CFP:
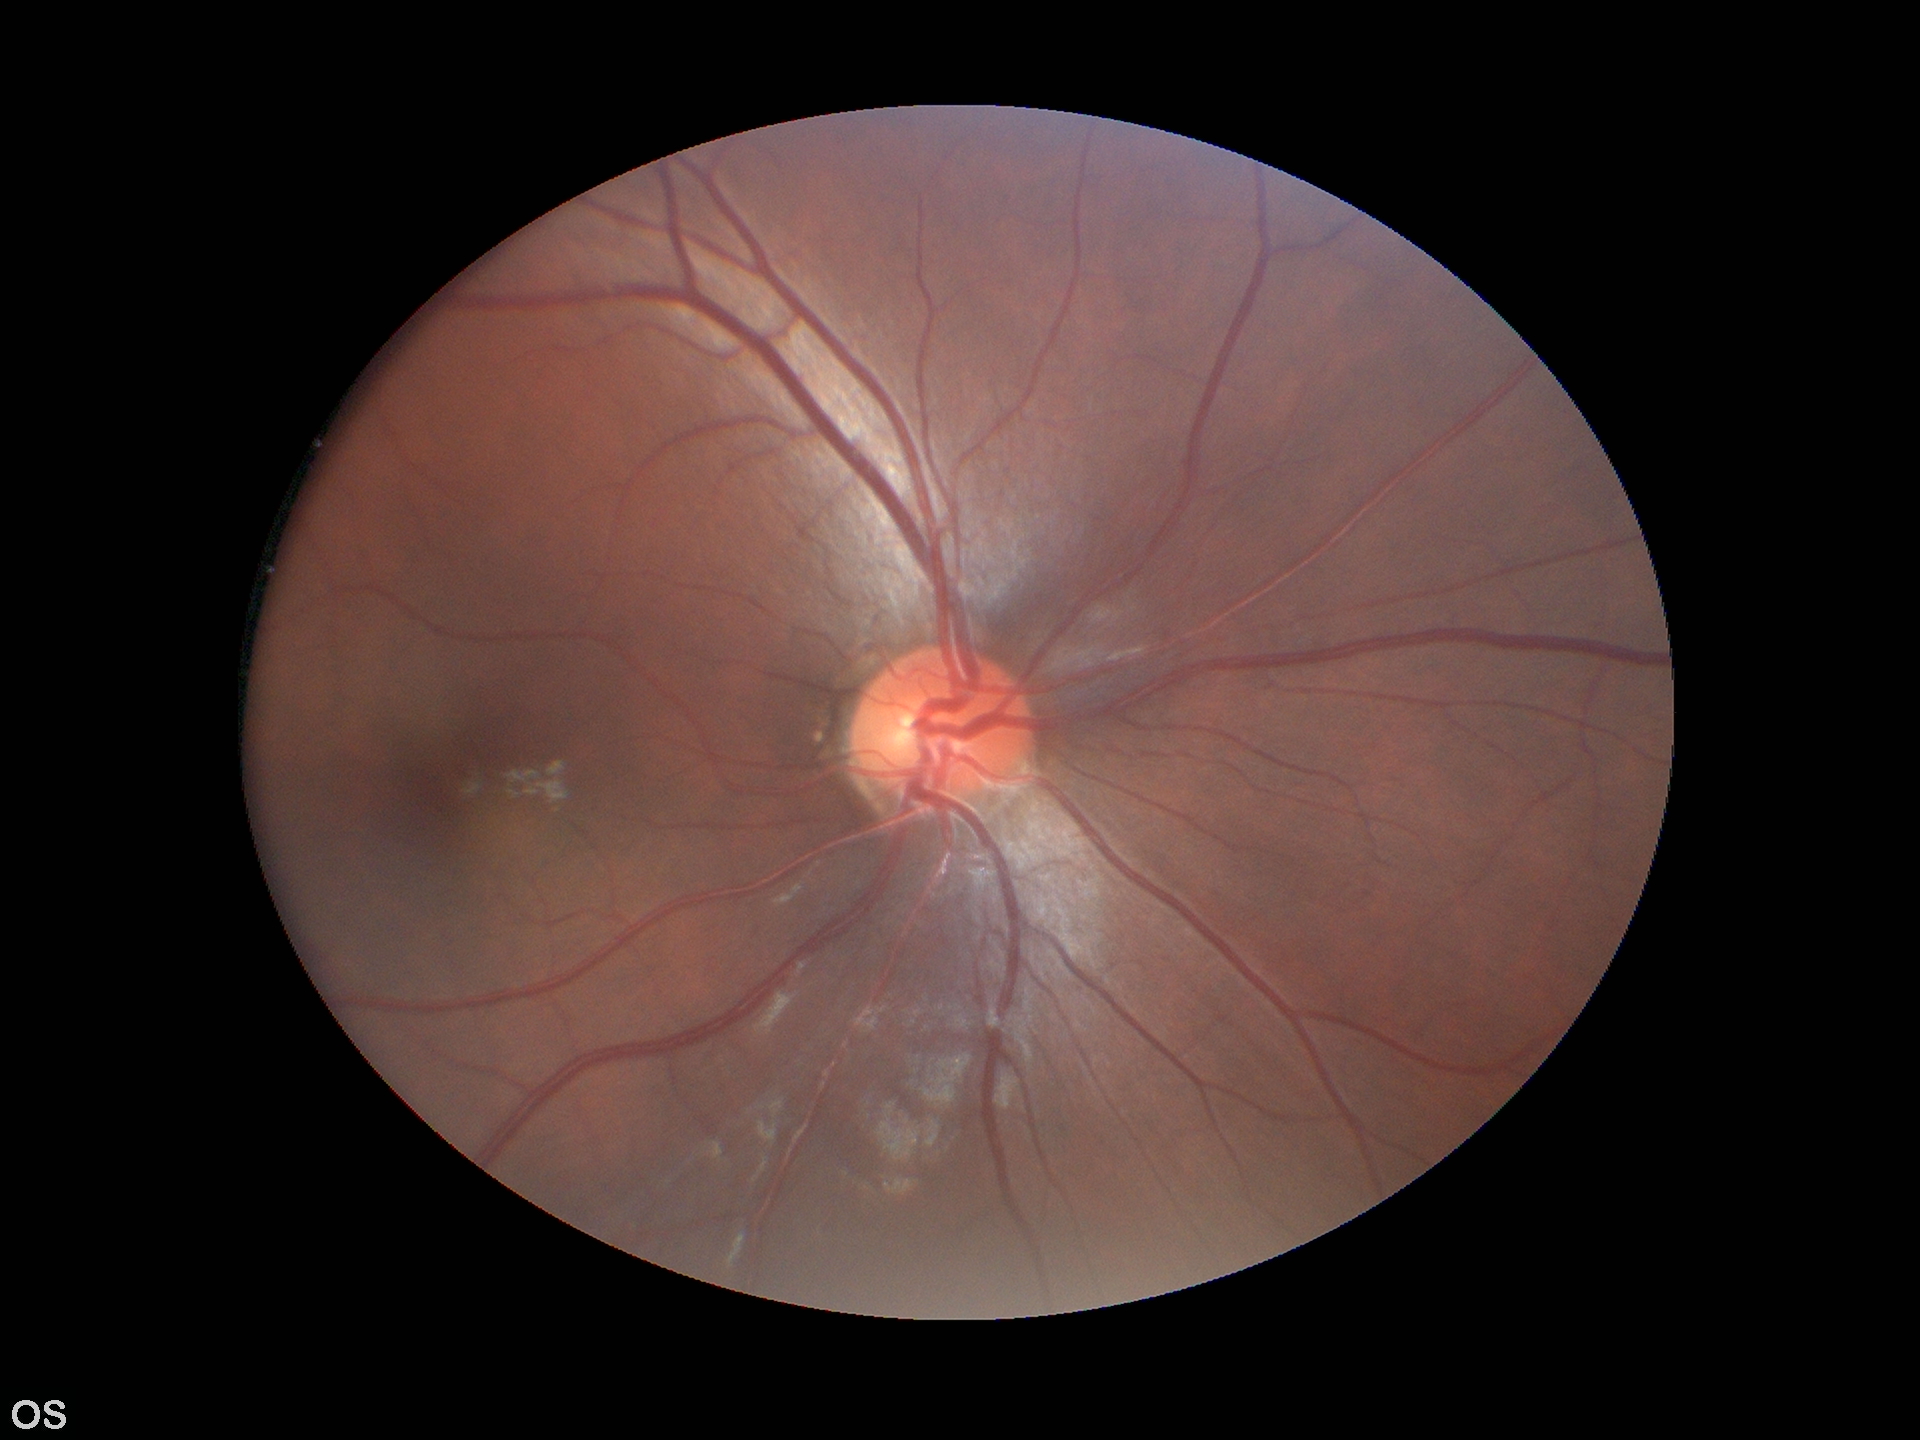
Glaucoma evaluation: negative (unanimous normal call)
horizontal CDR (HCDR): 0.43
vertical cup-to-disc ratio (VCDR): 0.43